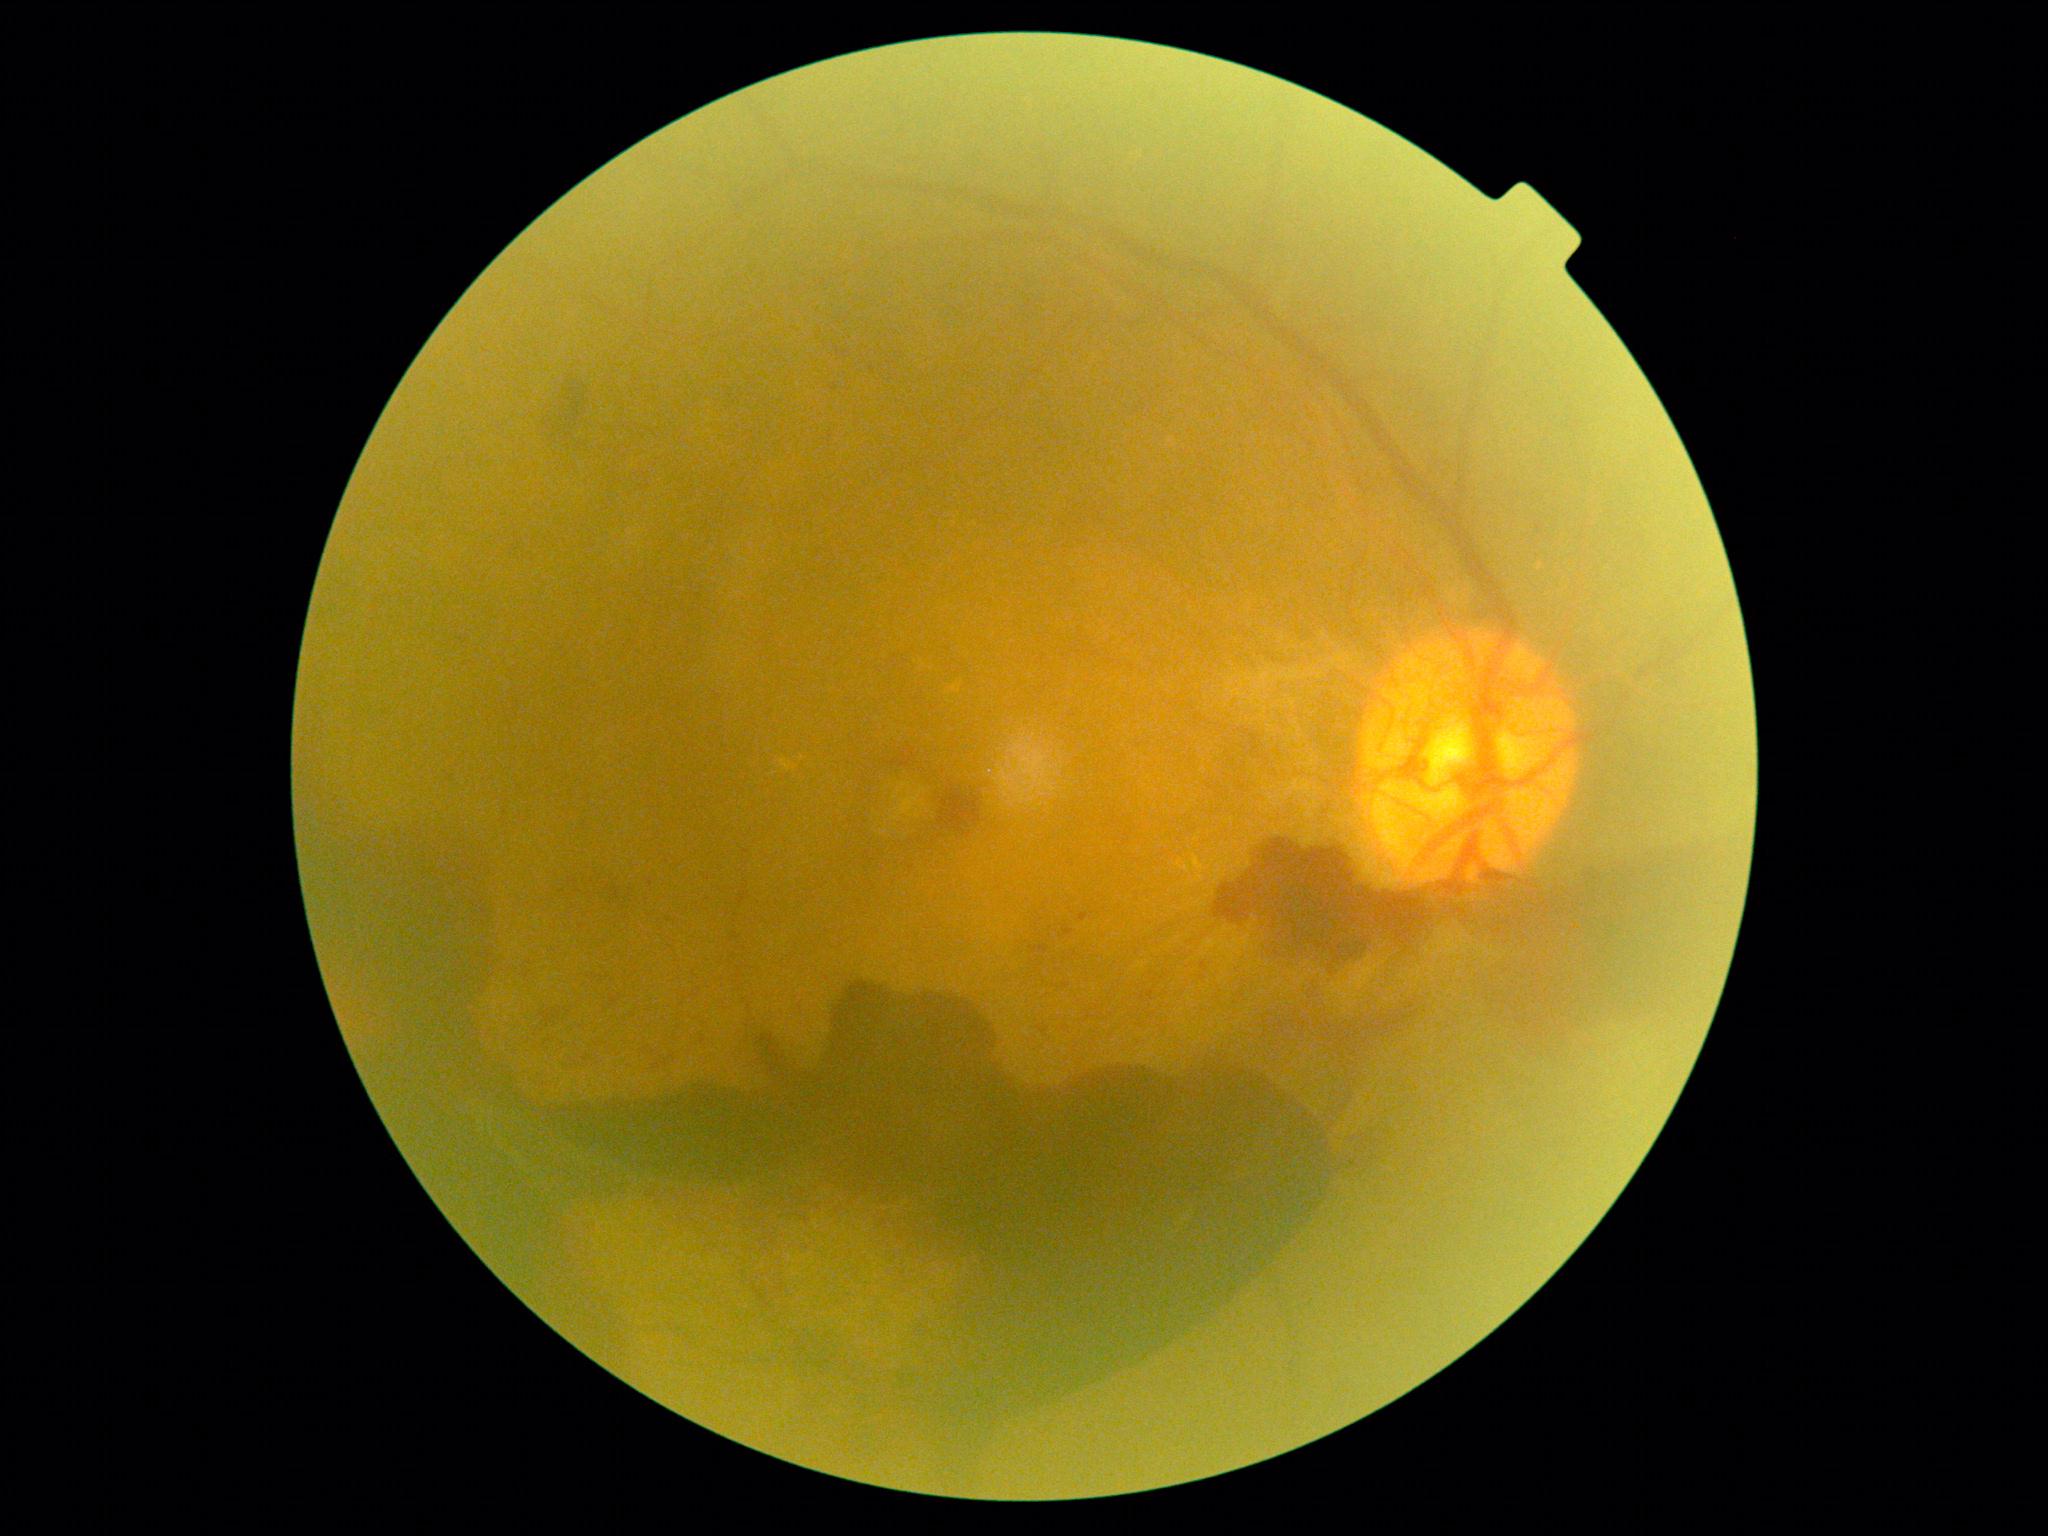

  dr_grade: PDR (4)